Retinal fundus photograph. Acquired with a Nidek AFC-330
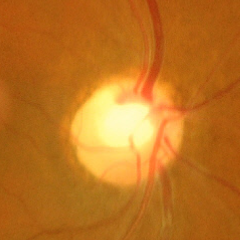

The image shows advanced glaucomatous optic neuropathy.